Infant wide-field retinal image
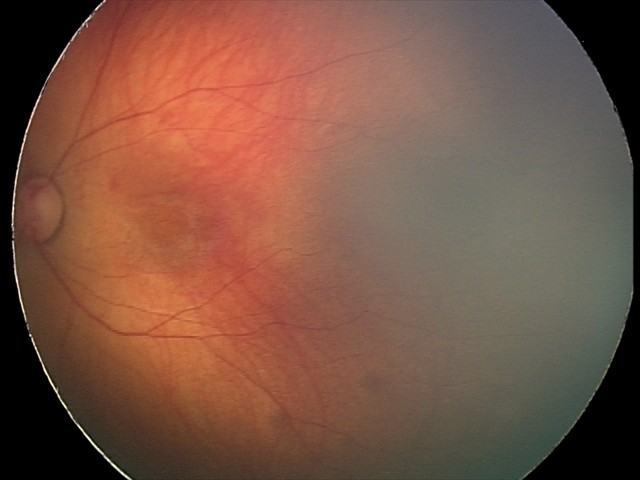

Series diagnosed as retinal hemorrhages.